Retinal fundus photograph · 1536x1152px · FOV: 45 degrees
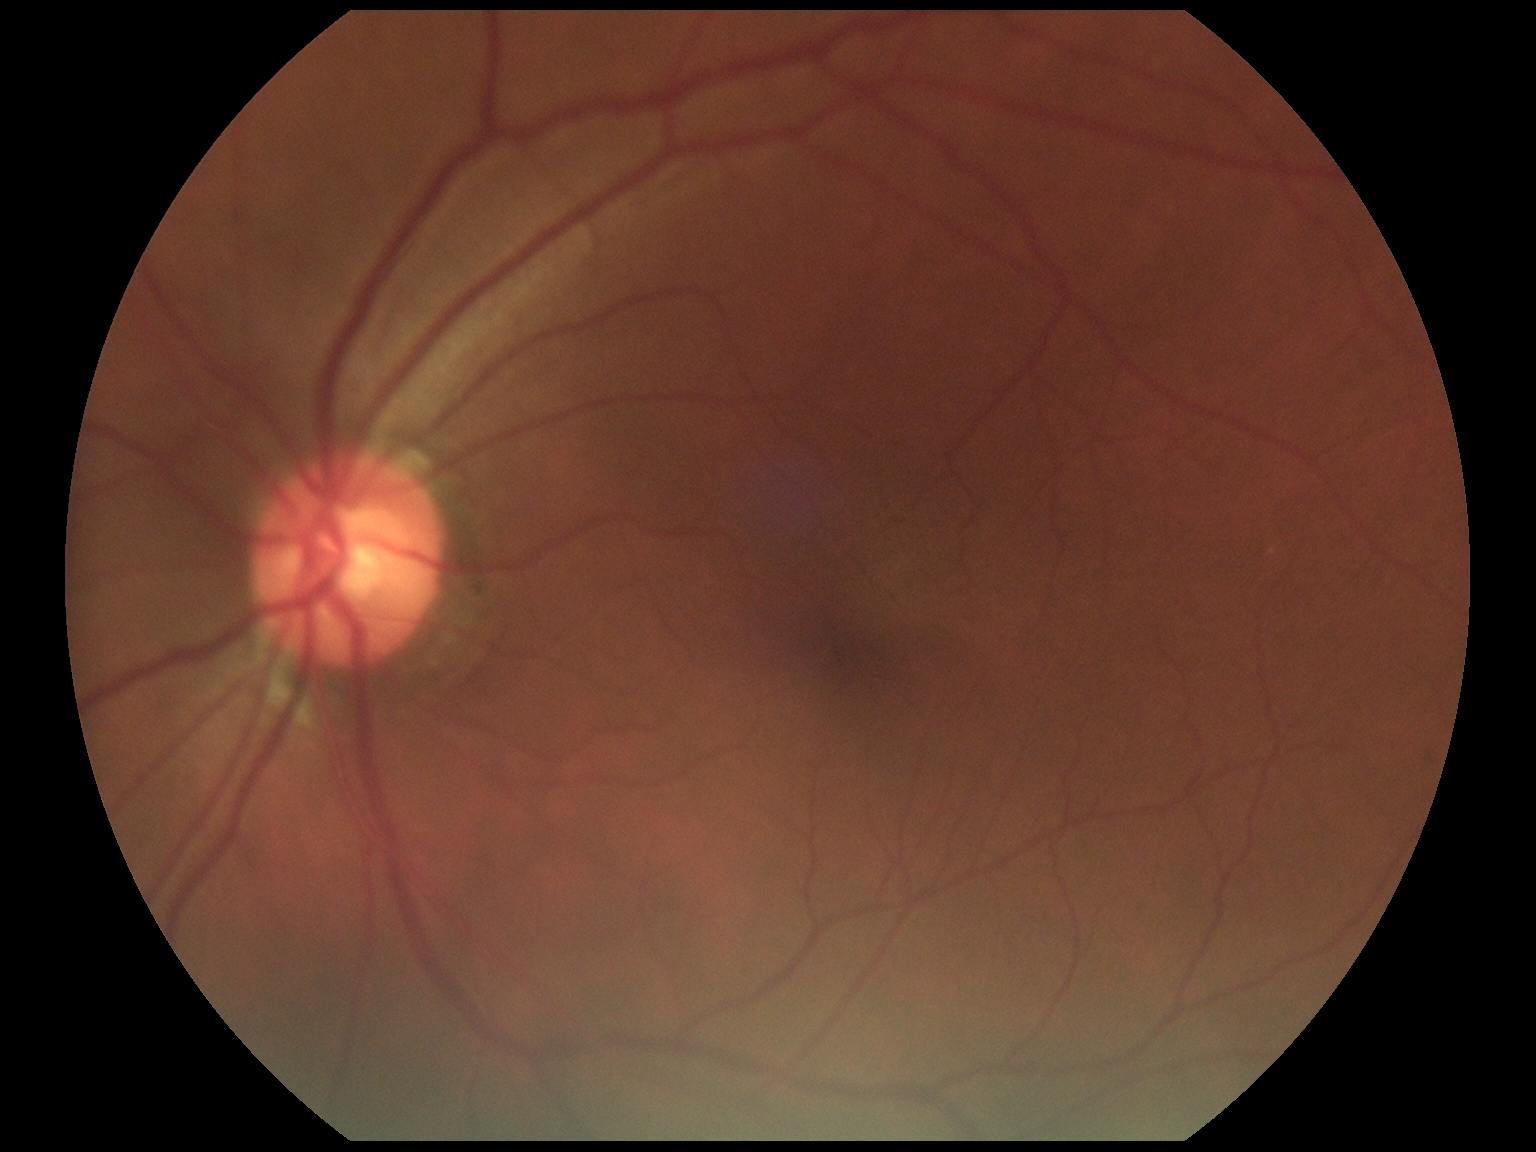

Annotations:
• DR impression: no DR findings
• DR severity: 0/4